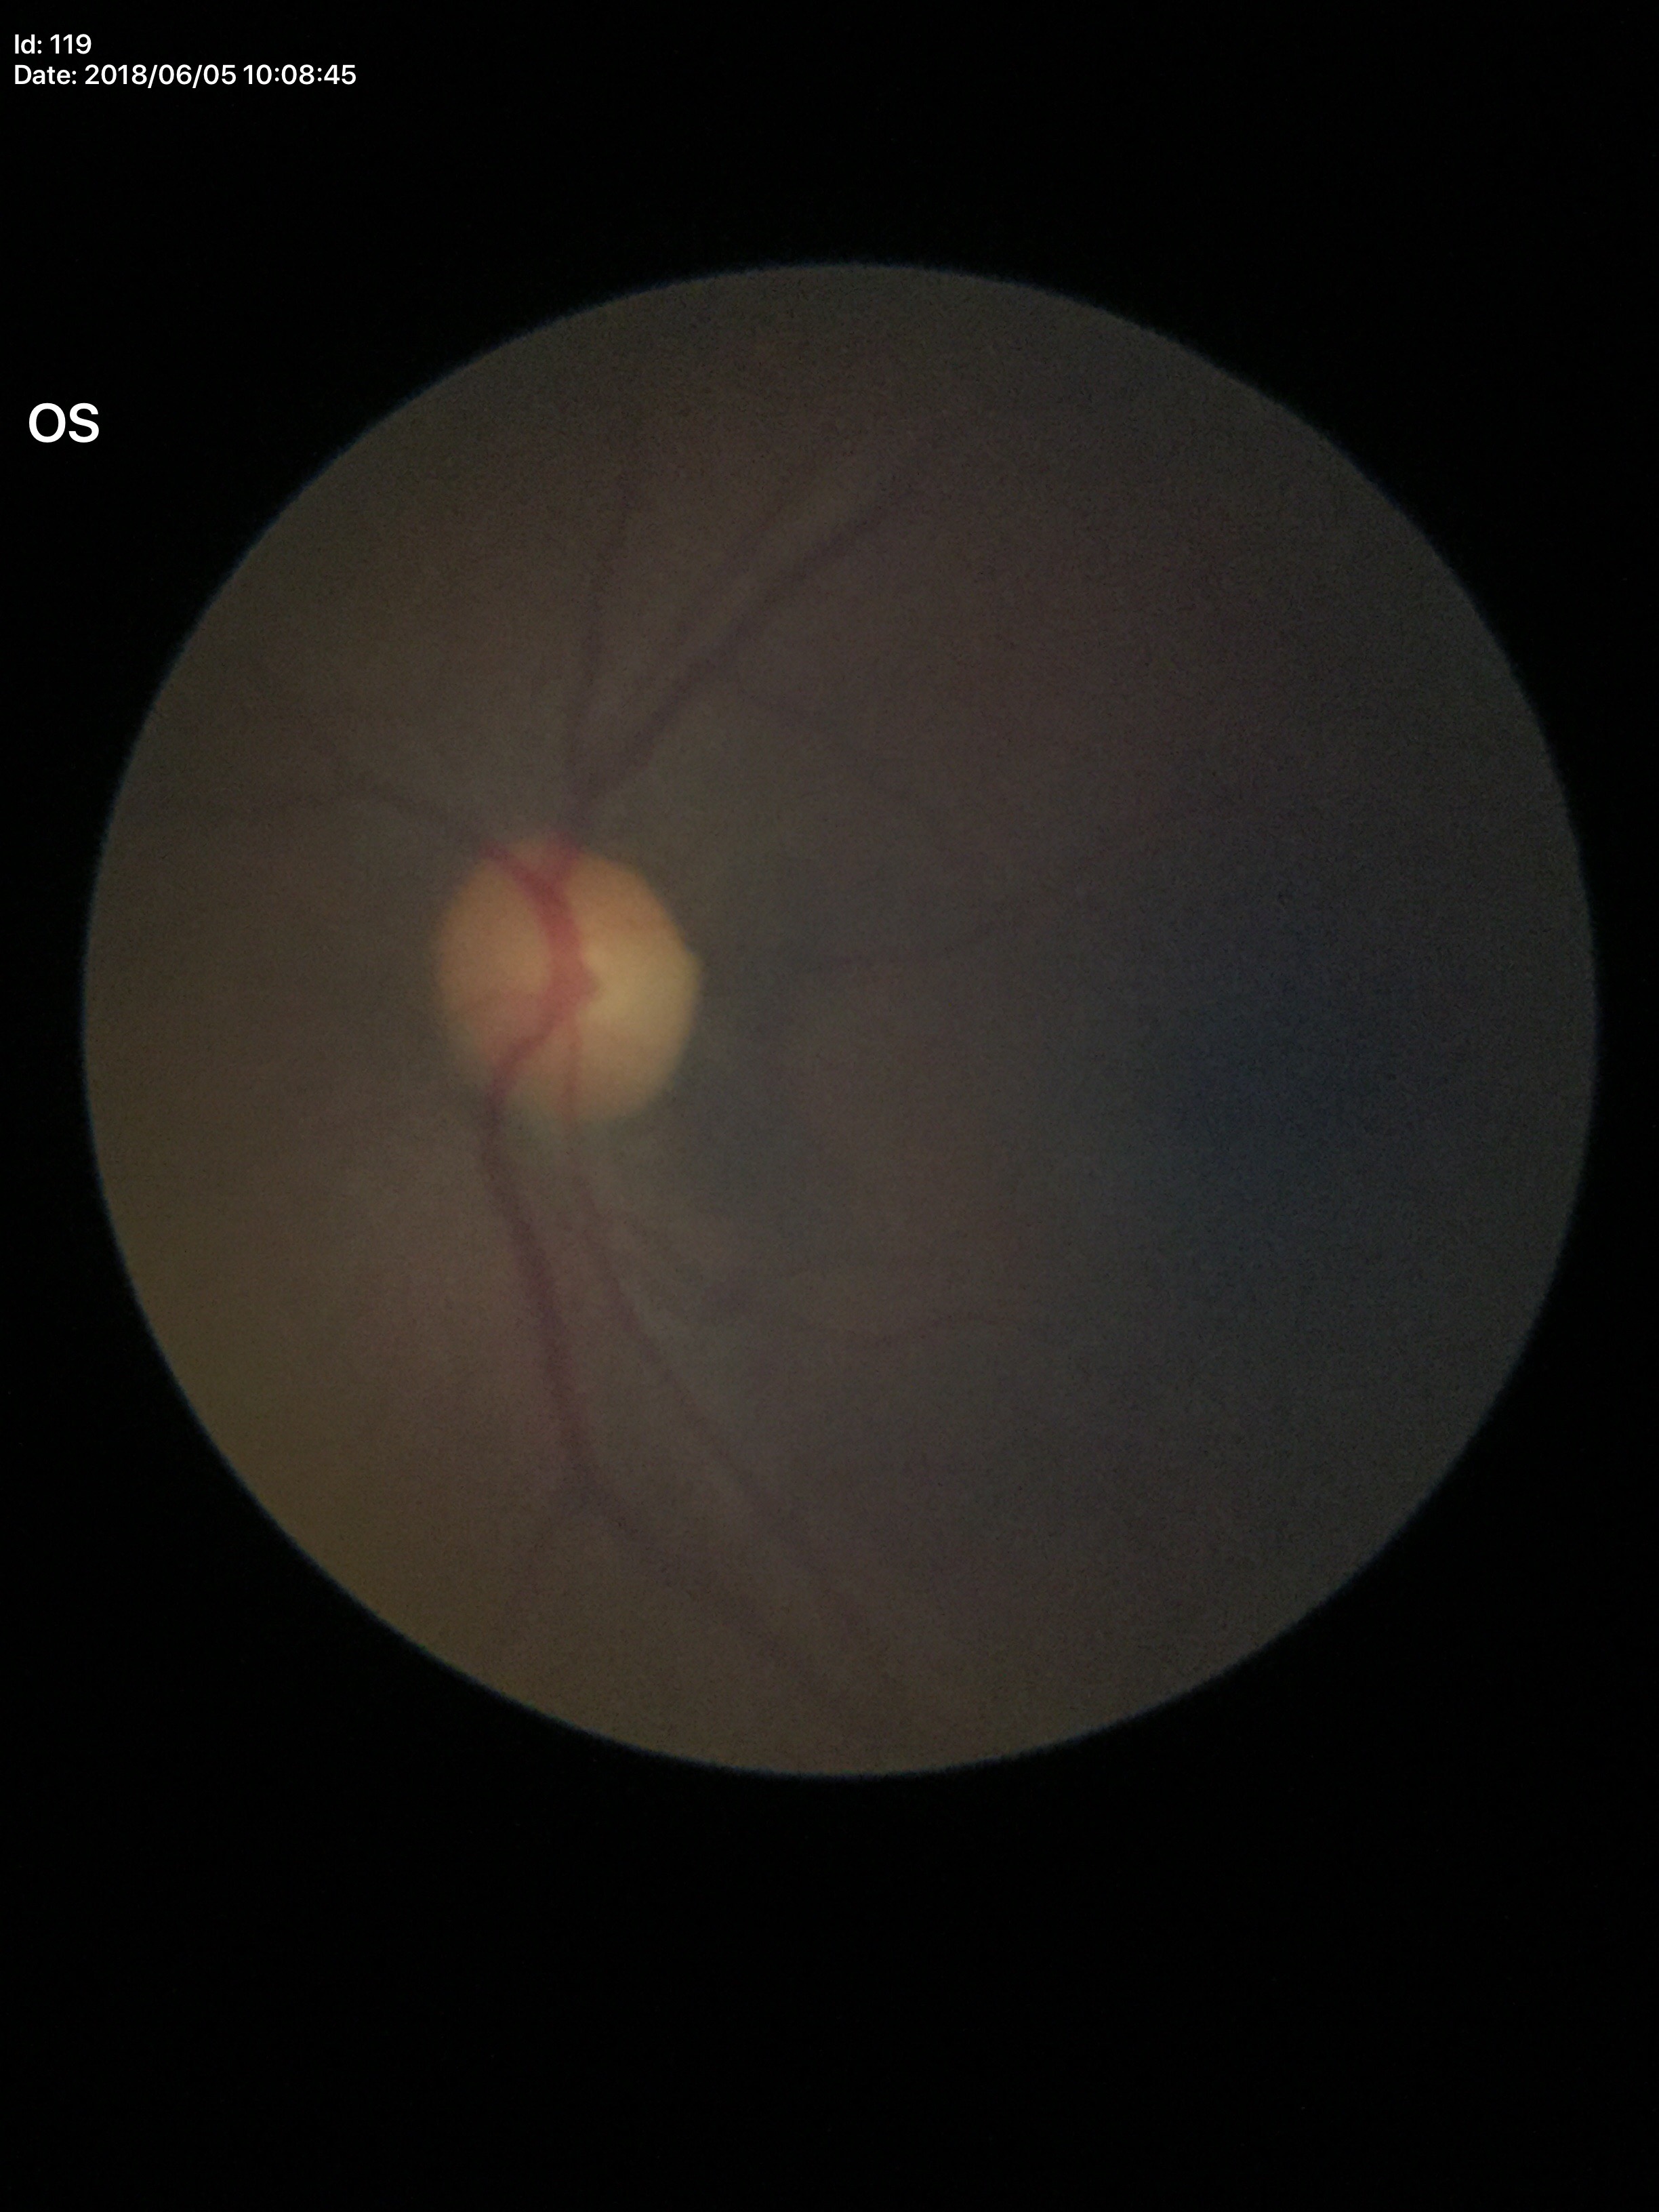 {"glaucoma_decision": "no suspicious findings", "vcdr": "0.44"}